45° FOV
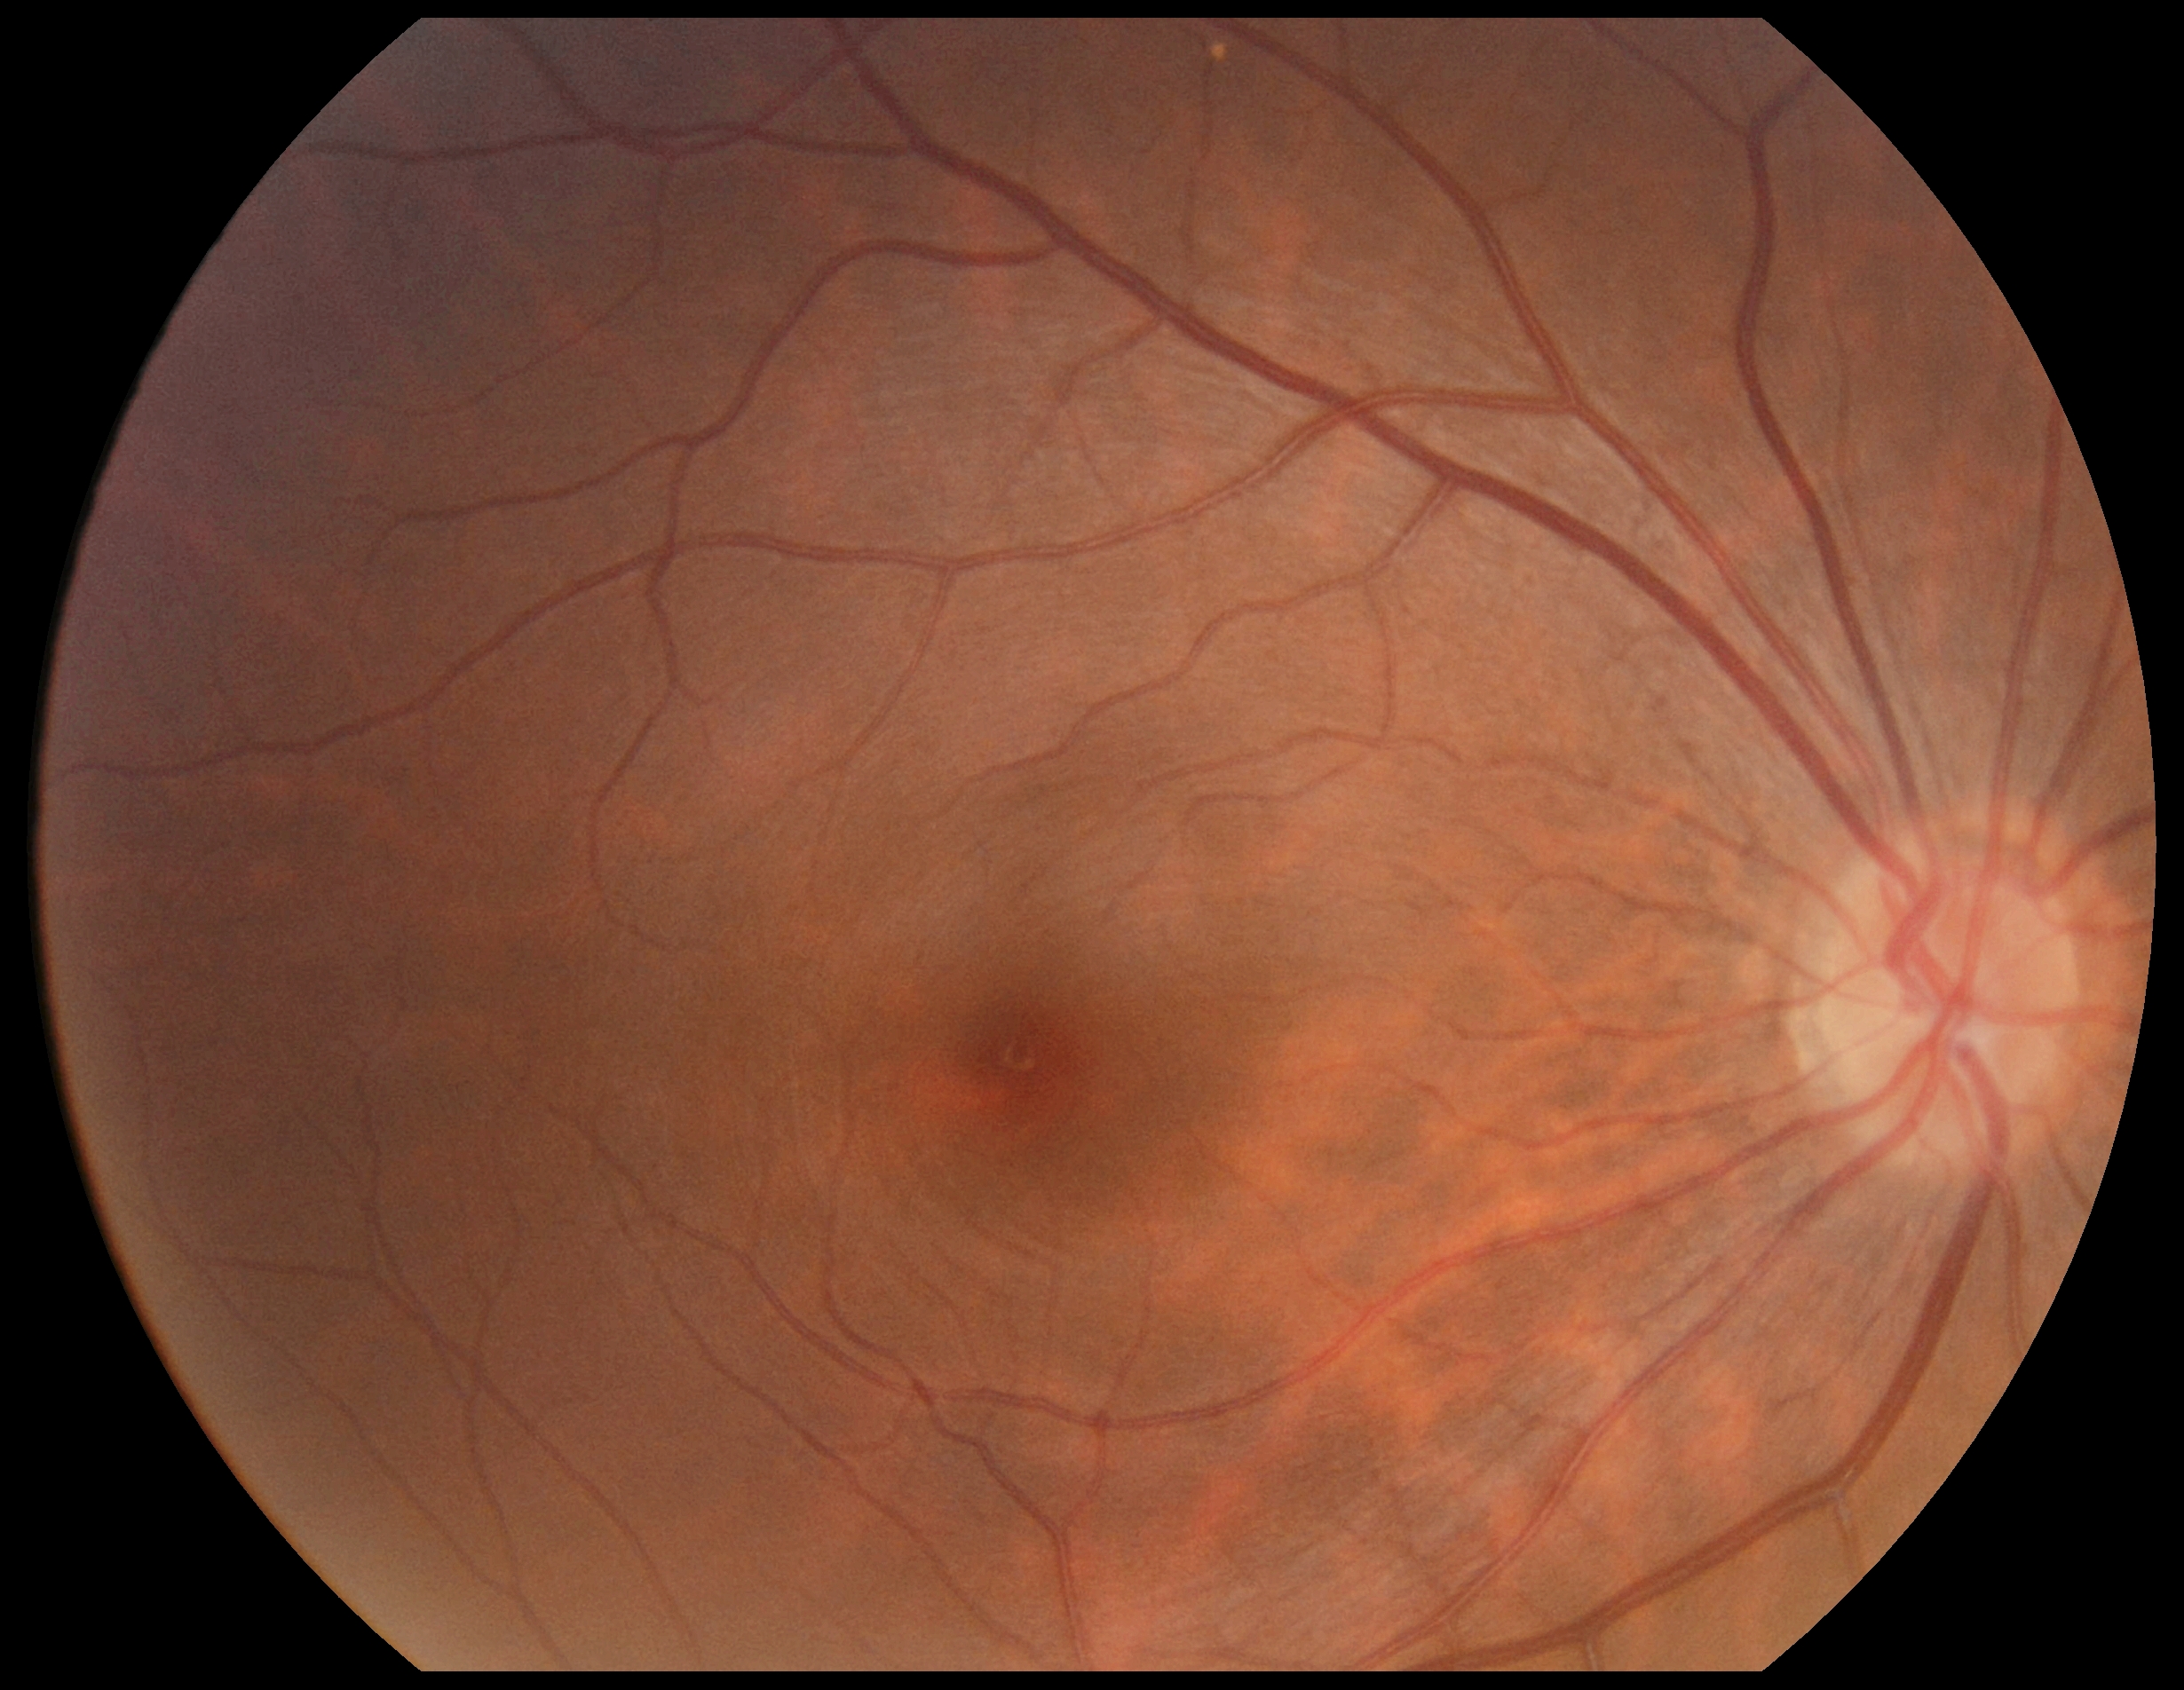
DR grade is 0. No diabetic retinal disease findings.